Field includes the optic disc and macula. Pupil-dilated. 50° field of view — 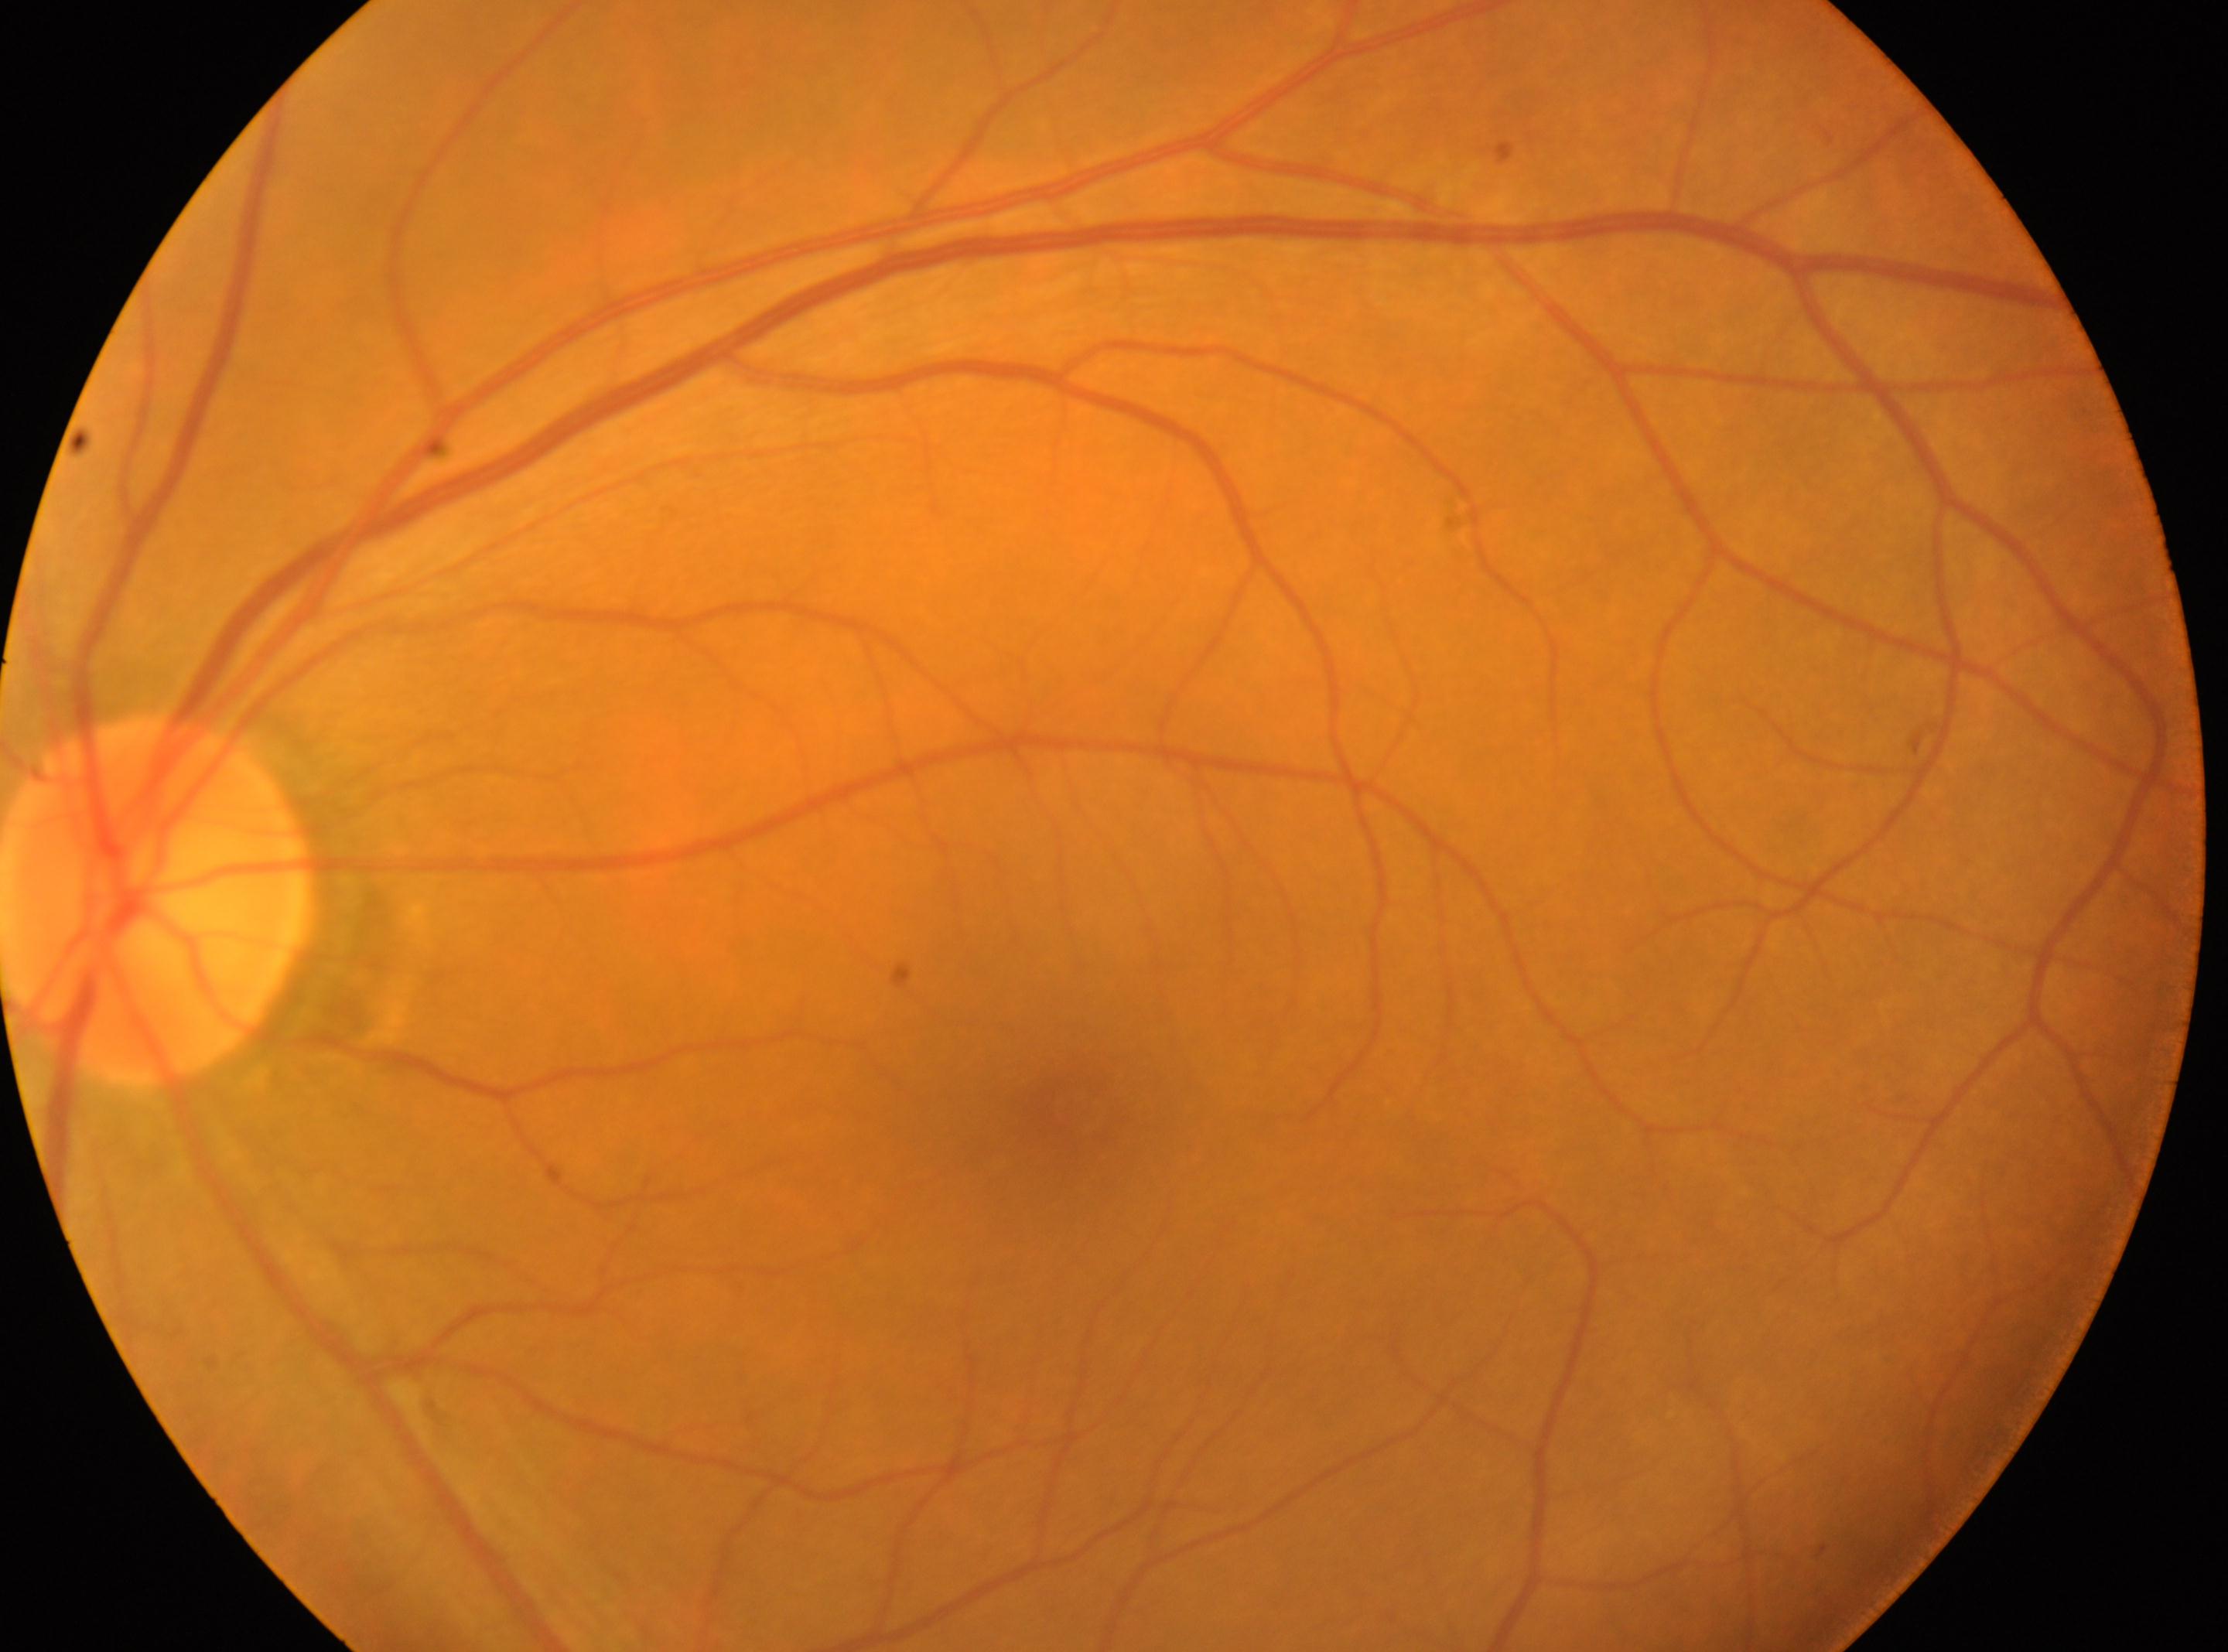 The image shows the oculus sinister. Fovea centralis: 1075, 1112. Diabetic retinopathy (DR) is grade 0 (no apparent retinopathy). The optic disc center is at 159, 903.